Modified Davis grading; acquired with a NIDEK AFC-230:
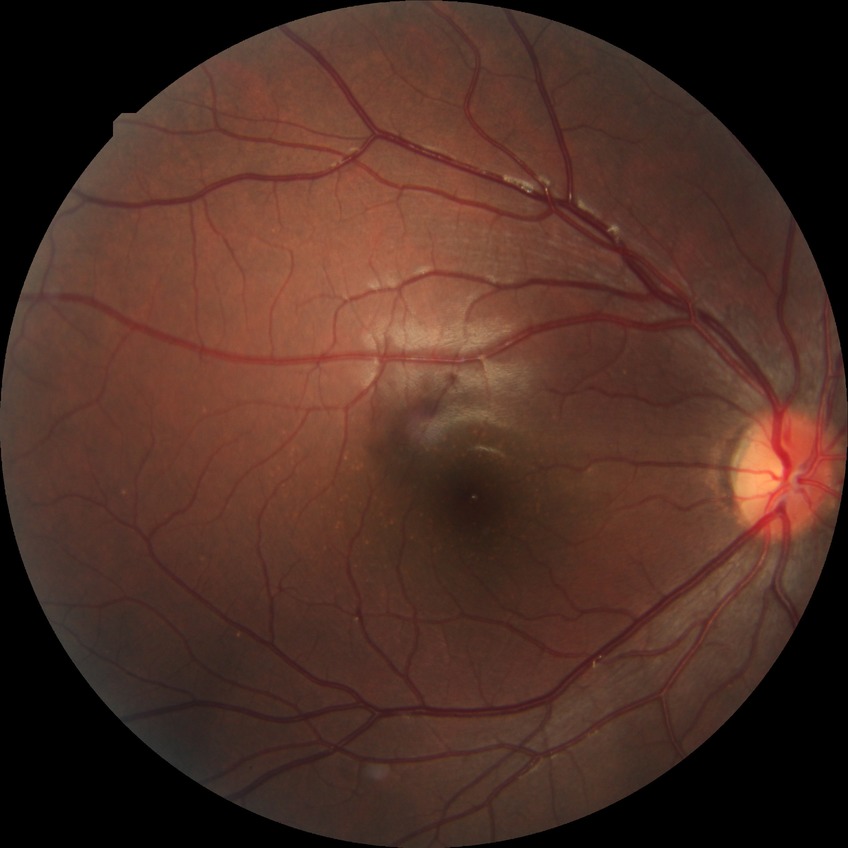

diabetic retinopathy stage: no diabetic retinopathy.